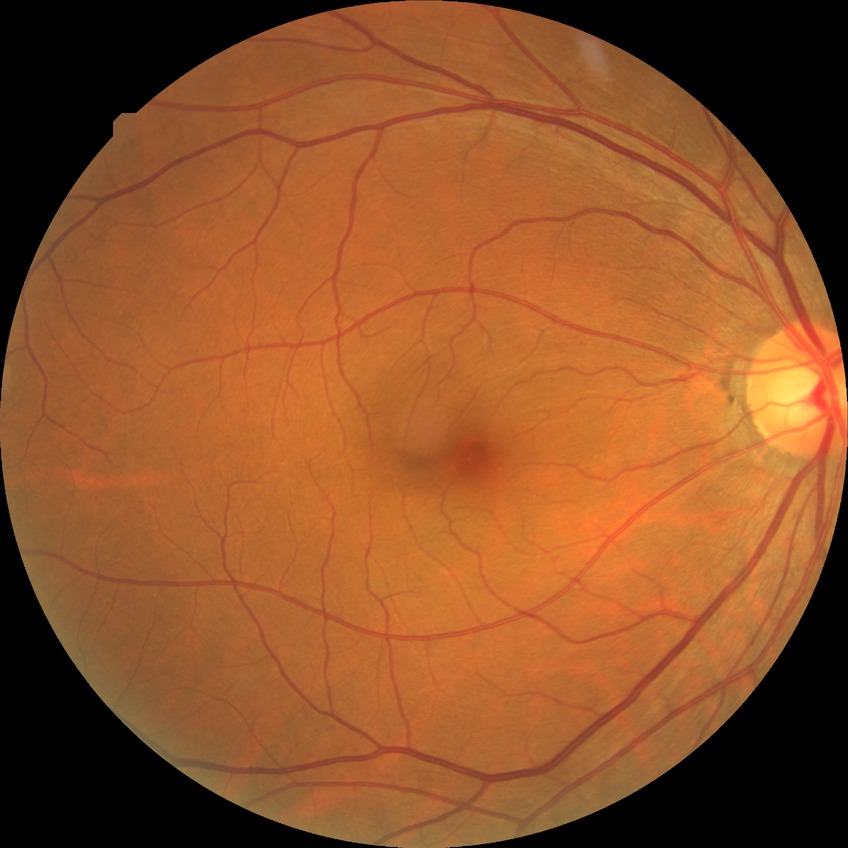 diabetic retinopathy (DR) = NDR (no diabetic retinopathy)